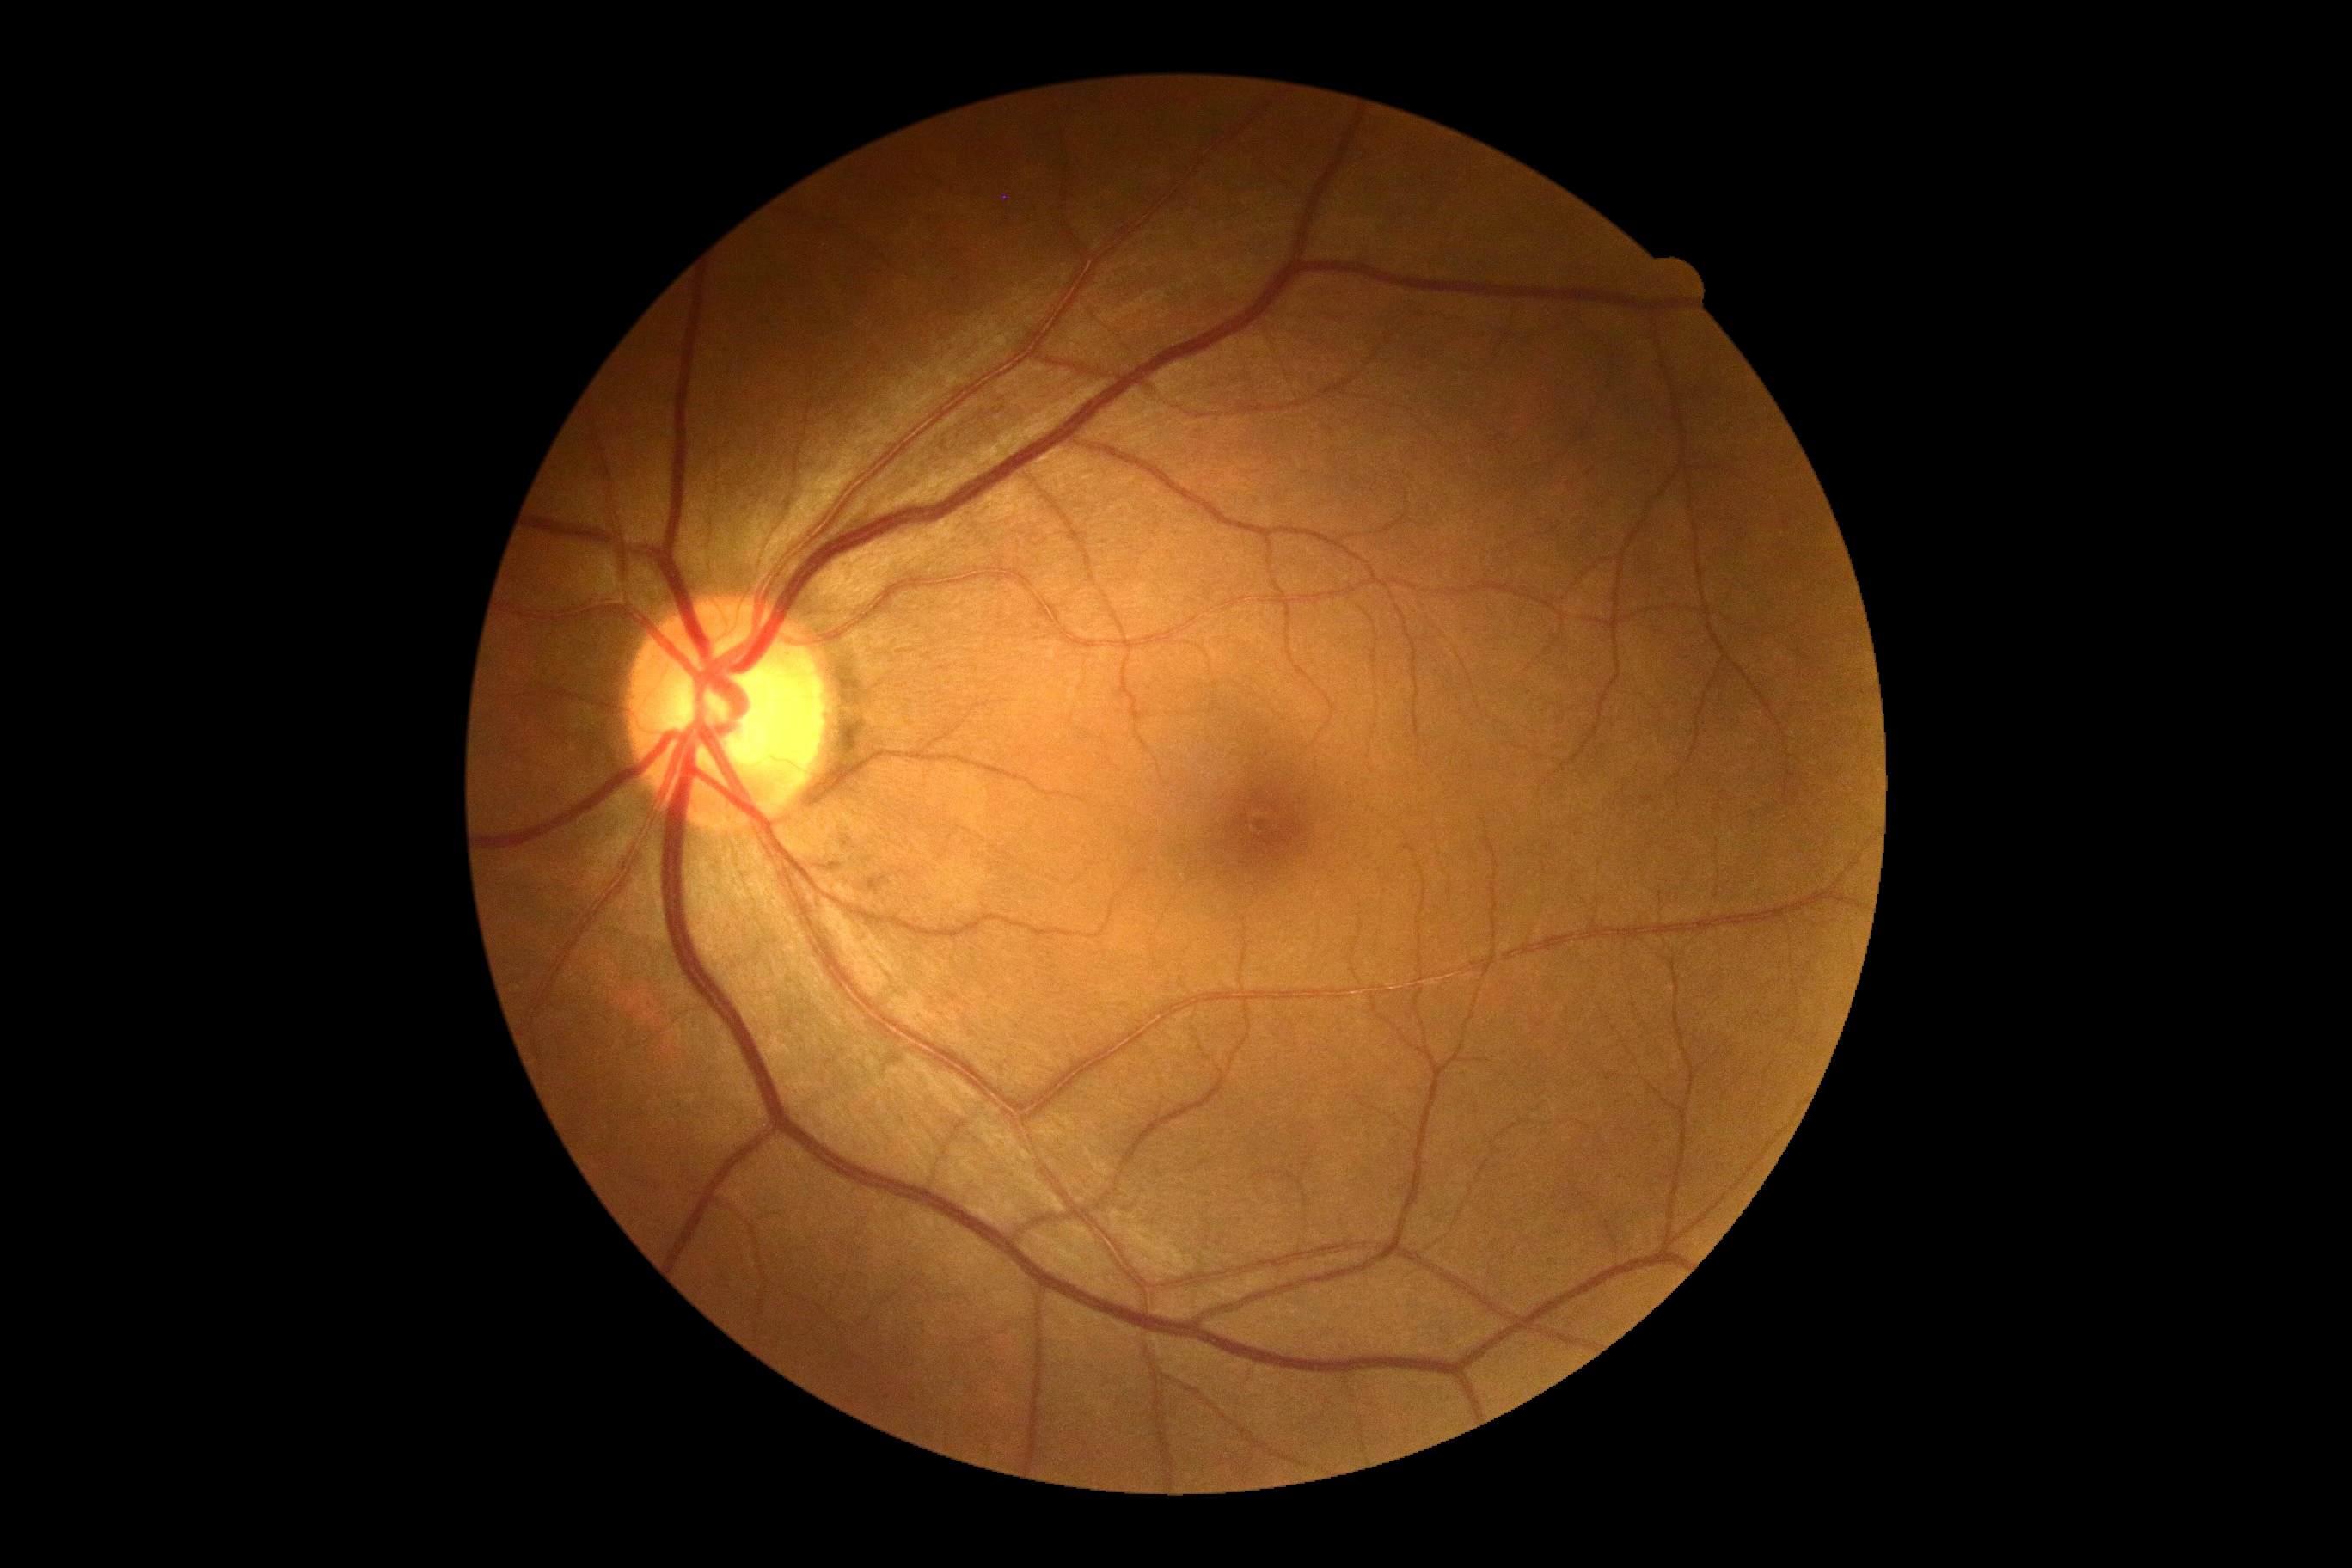
DR grade: 0. No DR findings.